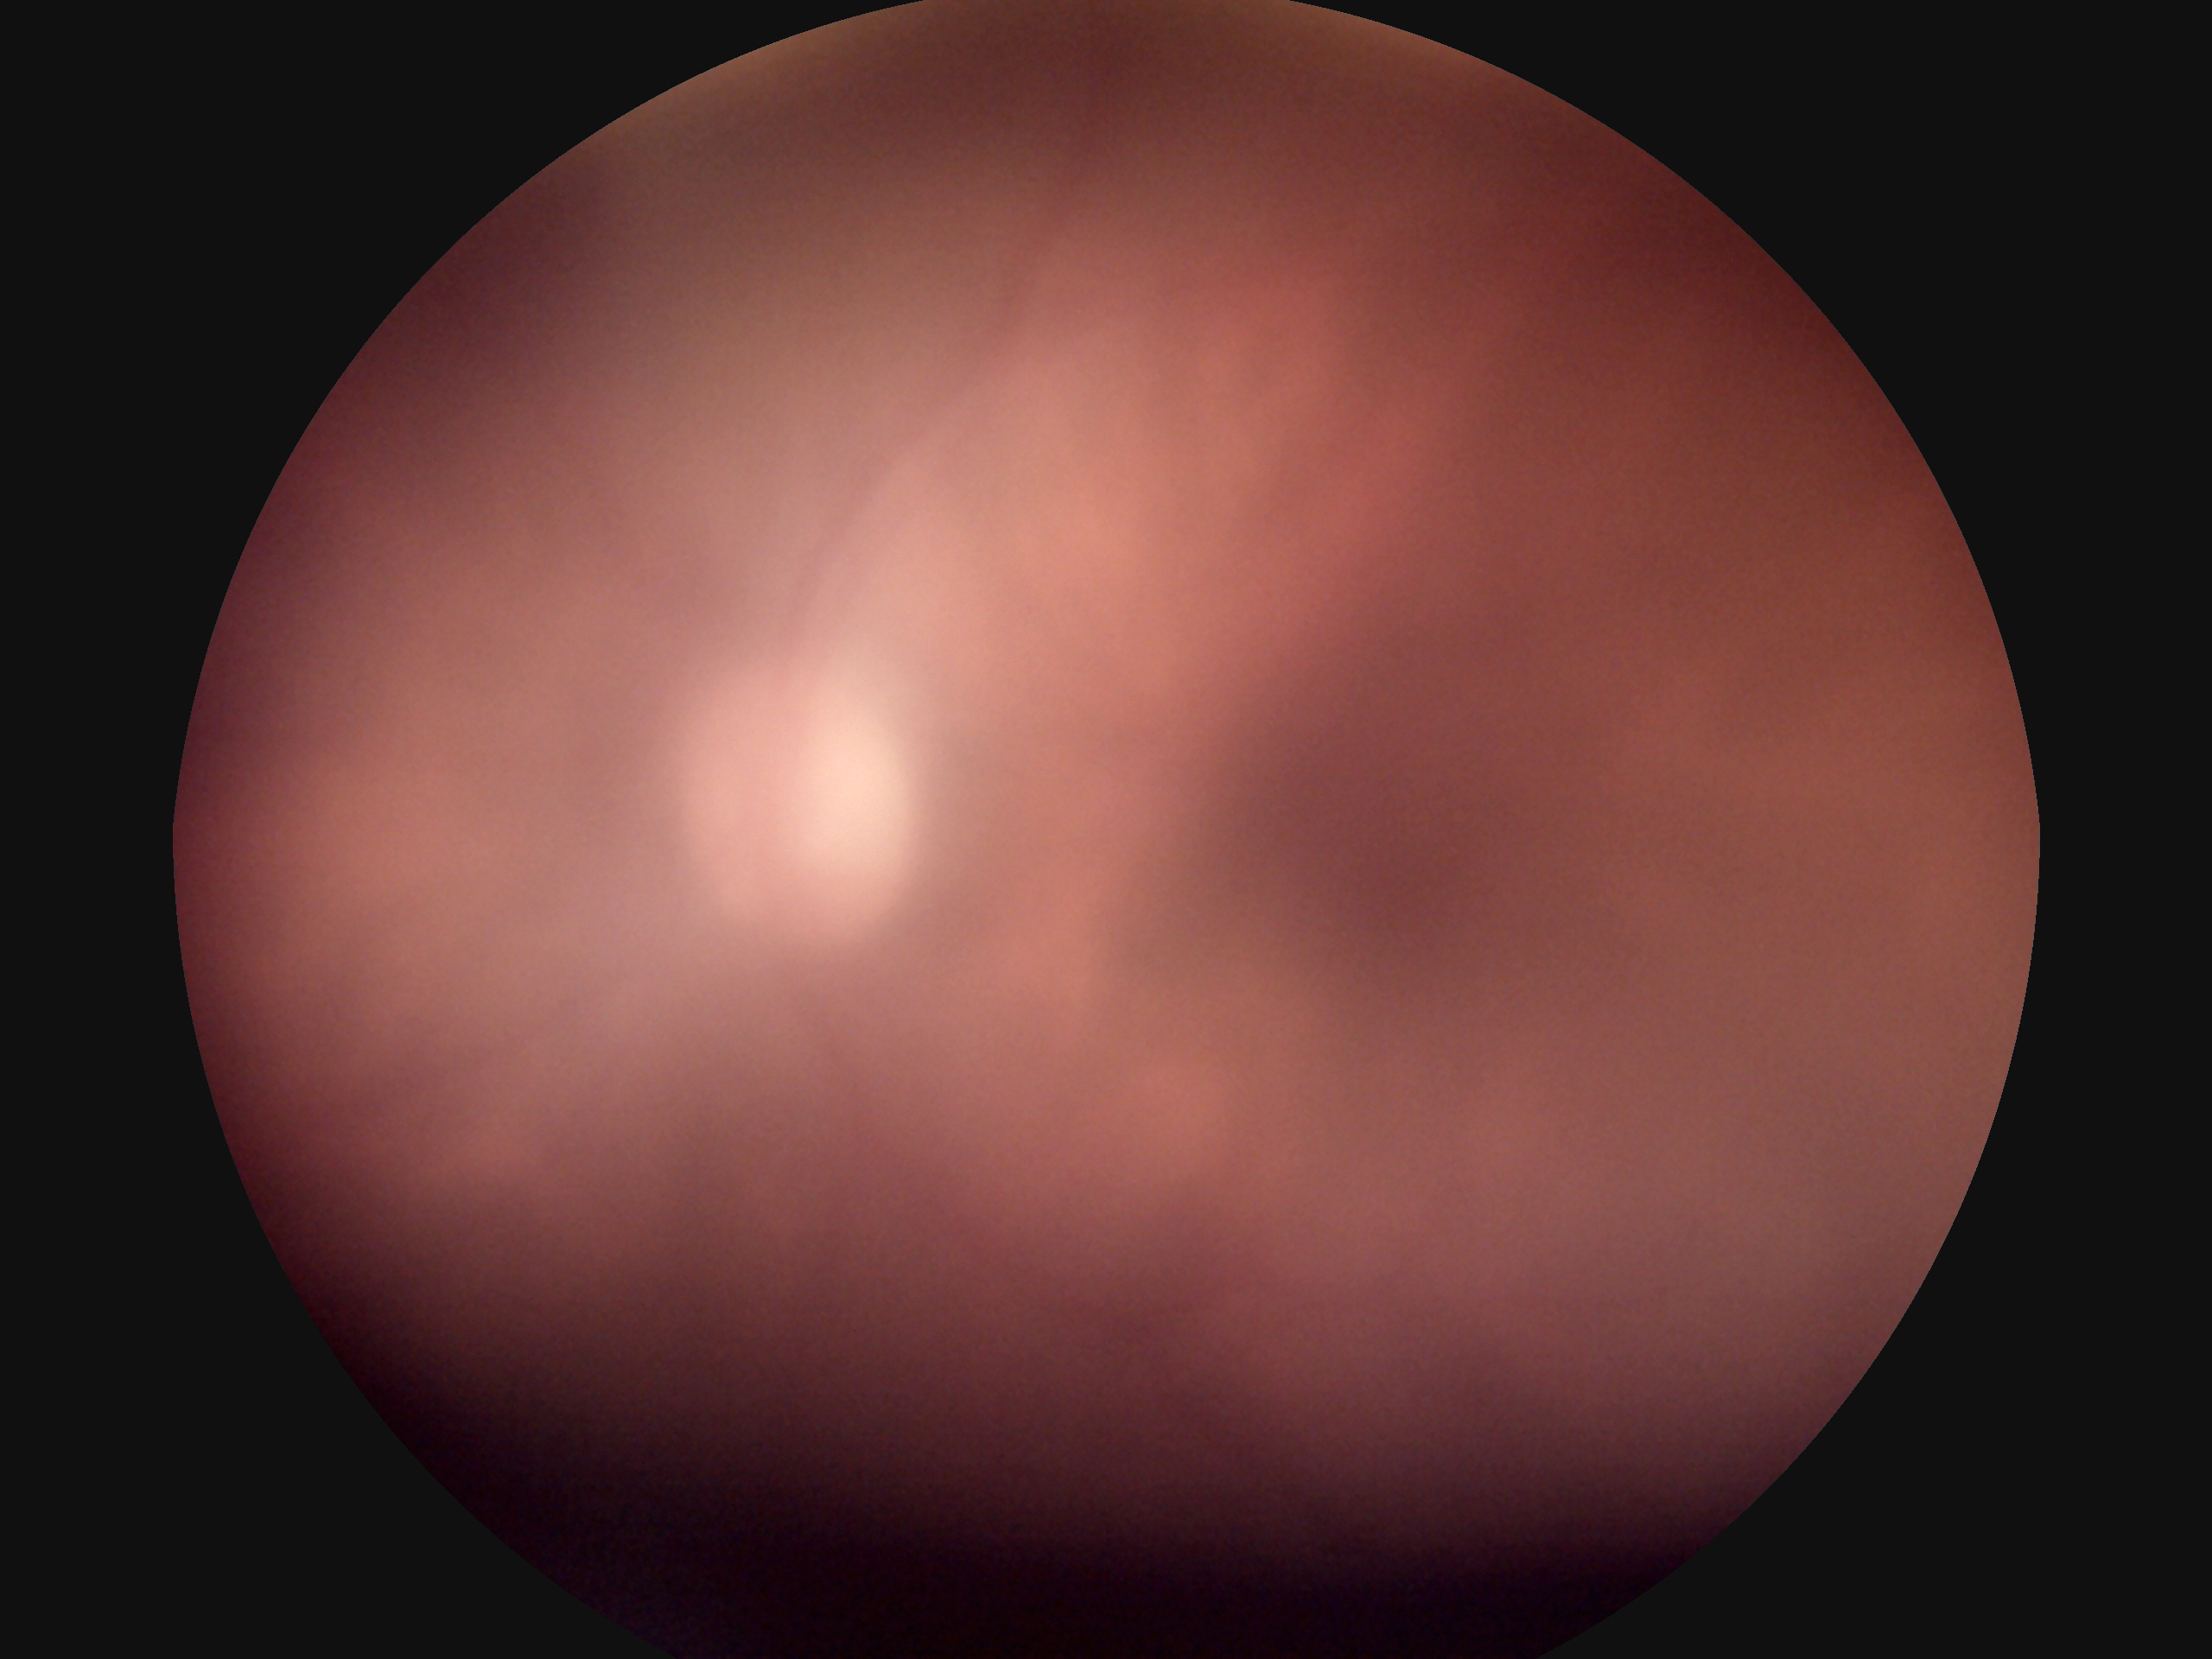 Diabetic retinopathy: ungradable due to poor image quality. The image cannot be graded for diabetic retinopathy.